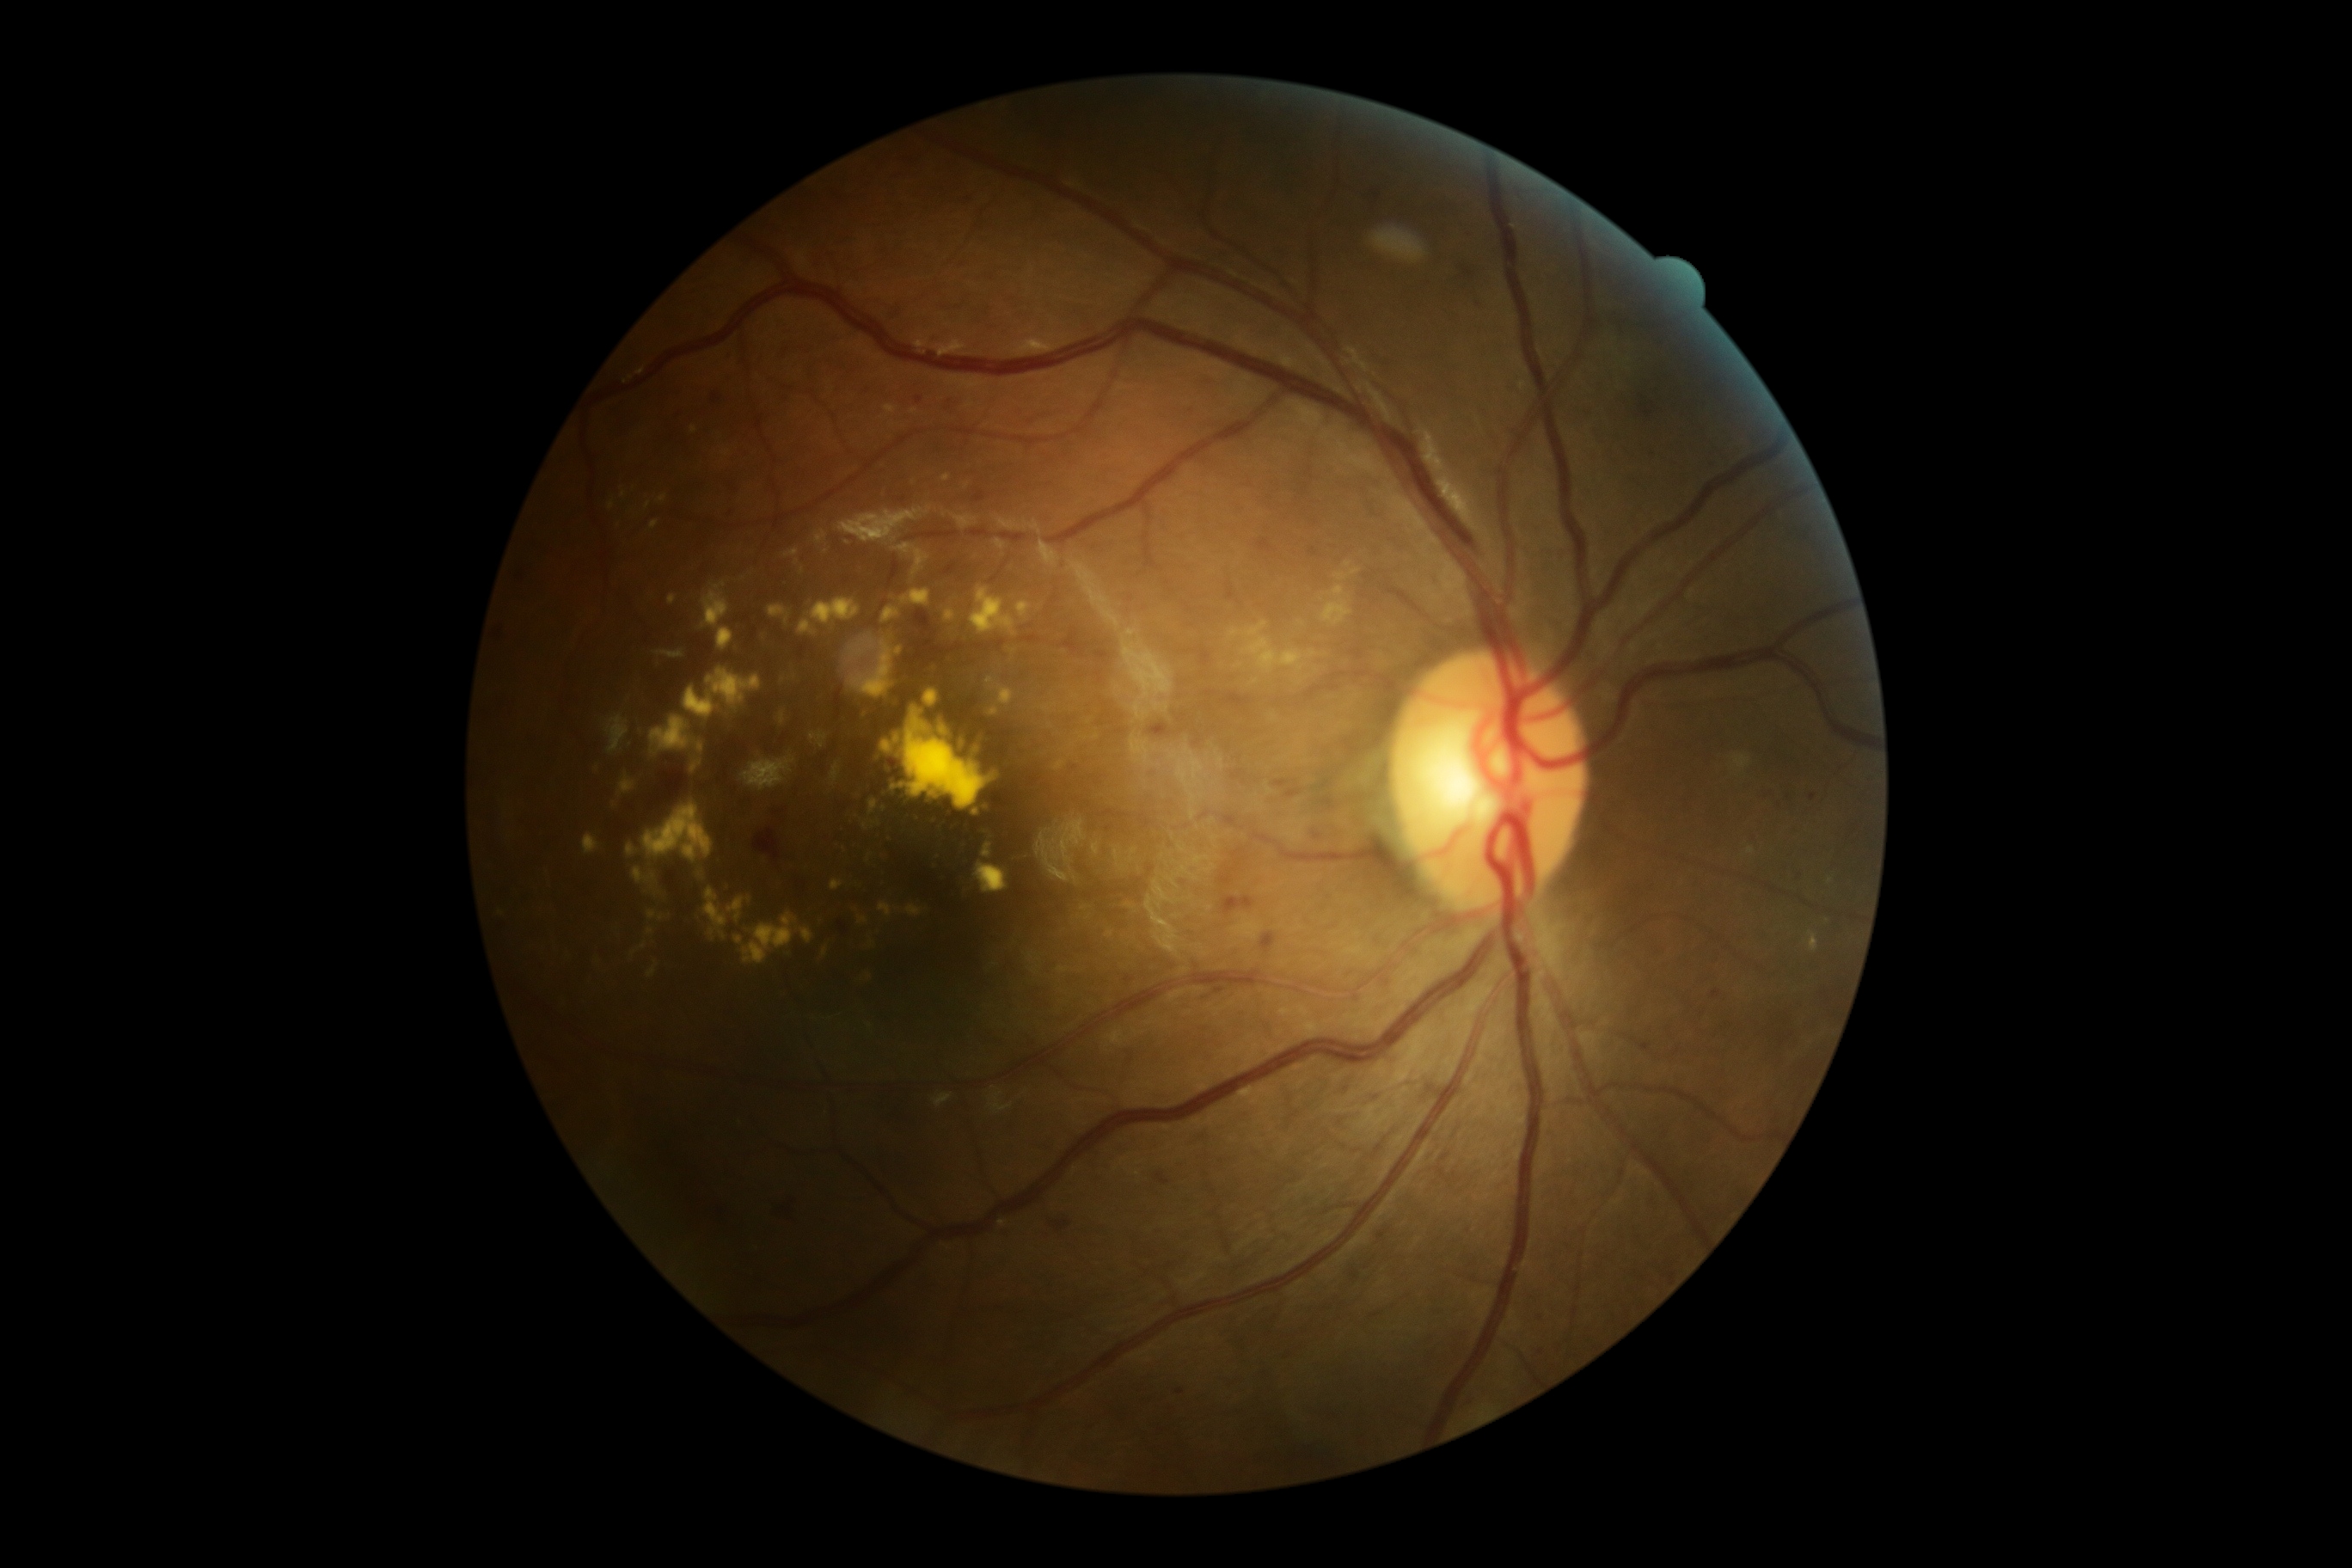 partial: true
dr_grade: 2
dr_grade_name: moderate NPDR
lesions:
  ex:
    - (940, 725, 948, 737)
    - (900, 589, 931, 608)
    - (704, 888, 728, 941)
    - (850, 646, 862, 656)
    - (962, 742, 965, 750)
    - (830, 763, 842, 788)
    - (1015, 601, 1031, 620)
    - (988, 706, 1000, 718)
    - (733, 914, 814, 965)
    - (905, 905, 924, 917)
    - (869, 799, 878, 816)
    - (584, 833, 601, 855)
    - (608, 501, 616, 510)
    - (1748, 848, 1756, 855)
    - (971, 587, 1017, 639)
    - (823, 948, 828, 957)
    - (651, 522, 659, 529)
  ex_small:
    - (976, 813)
    - (597, 769)
    - (872, 944)